Infant wide-field fundus photograph · 640x480: 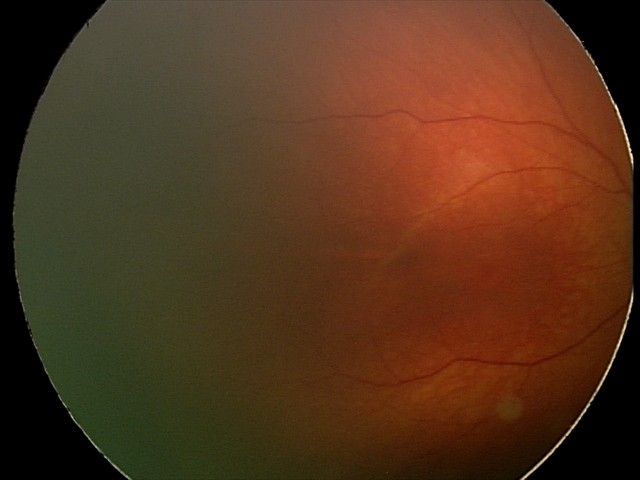
Diagnosis = no pathology identified